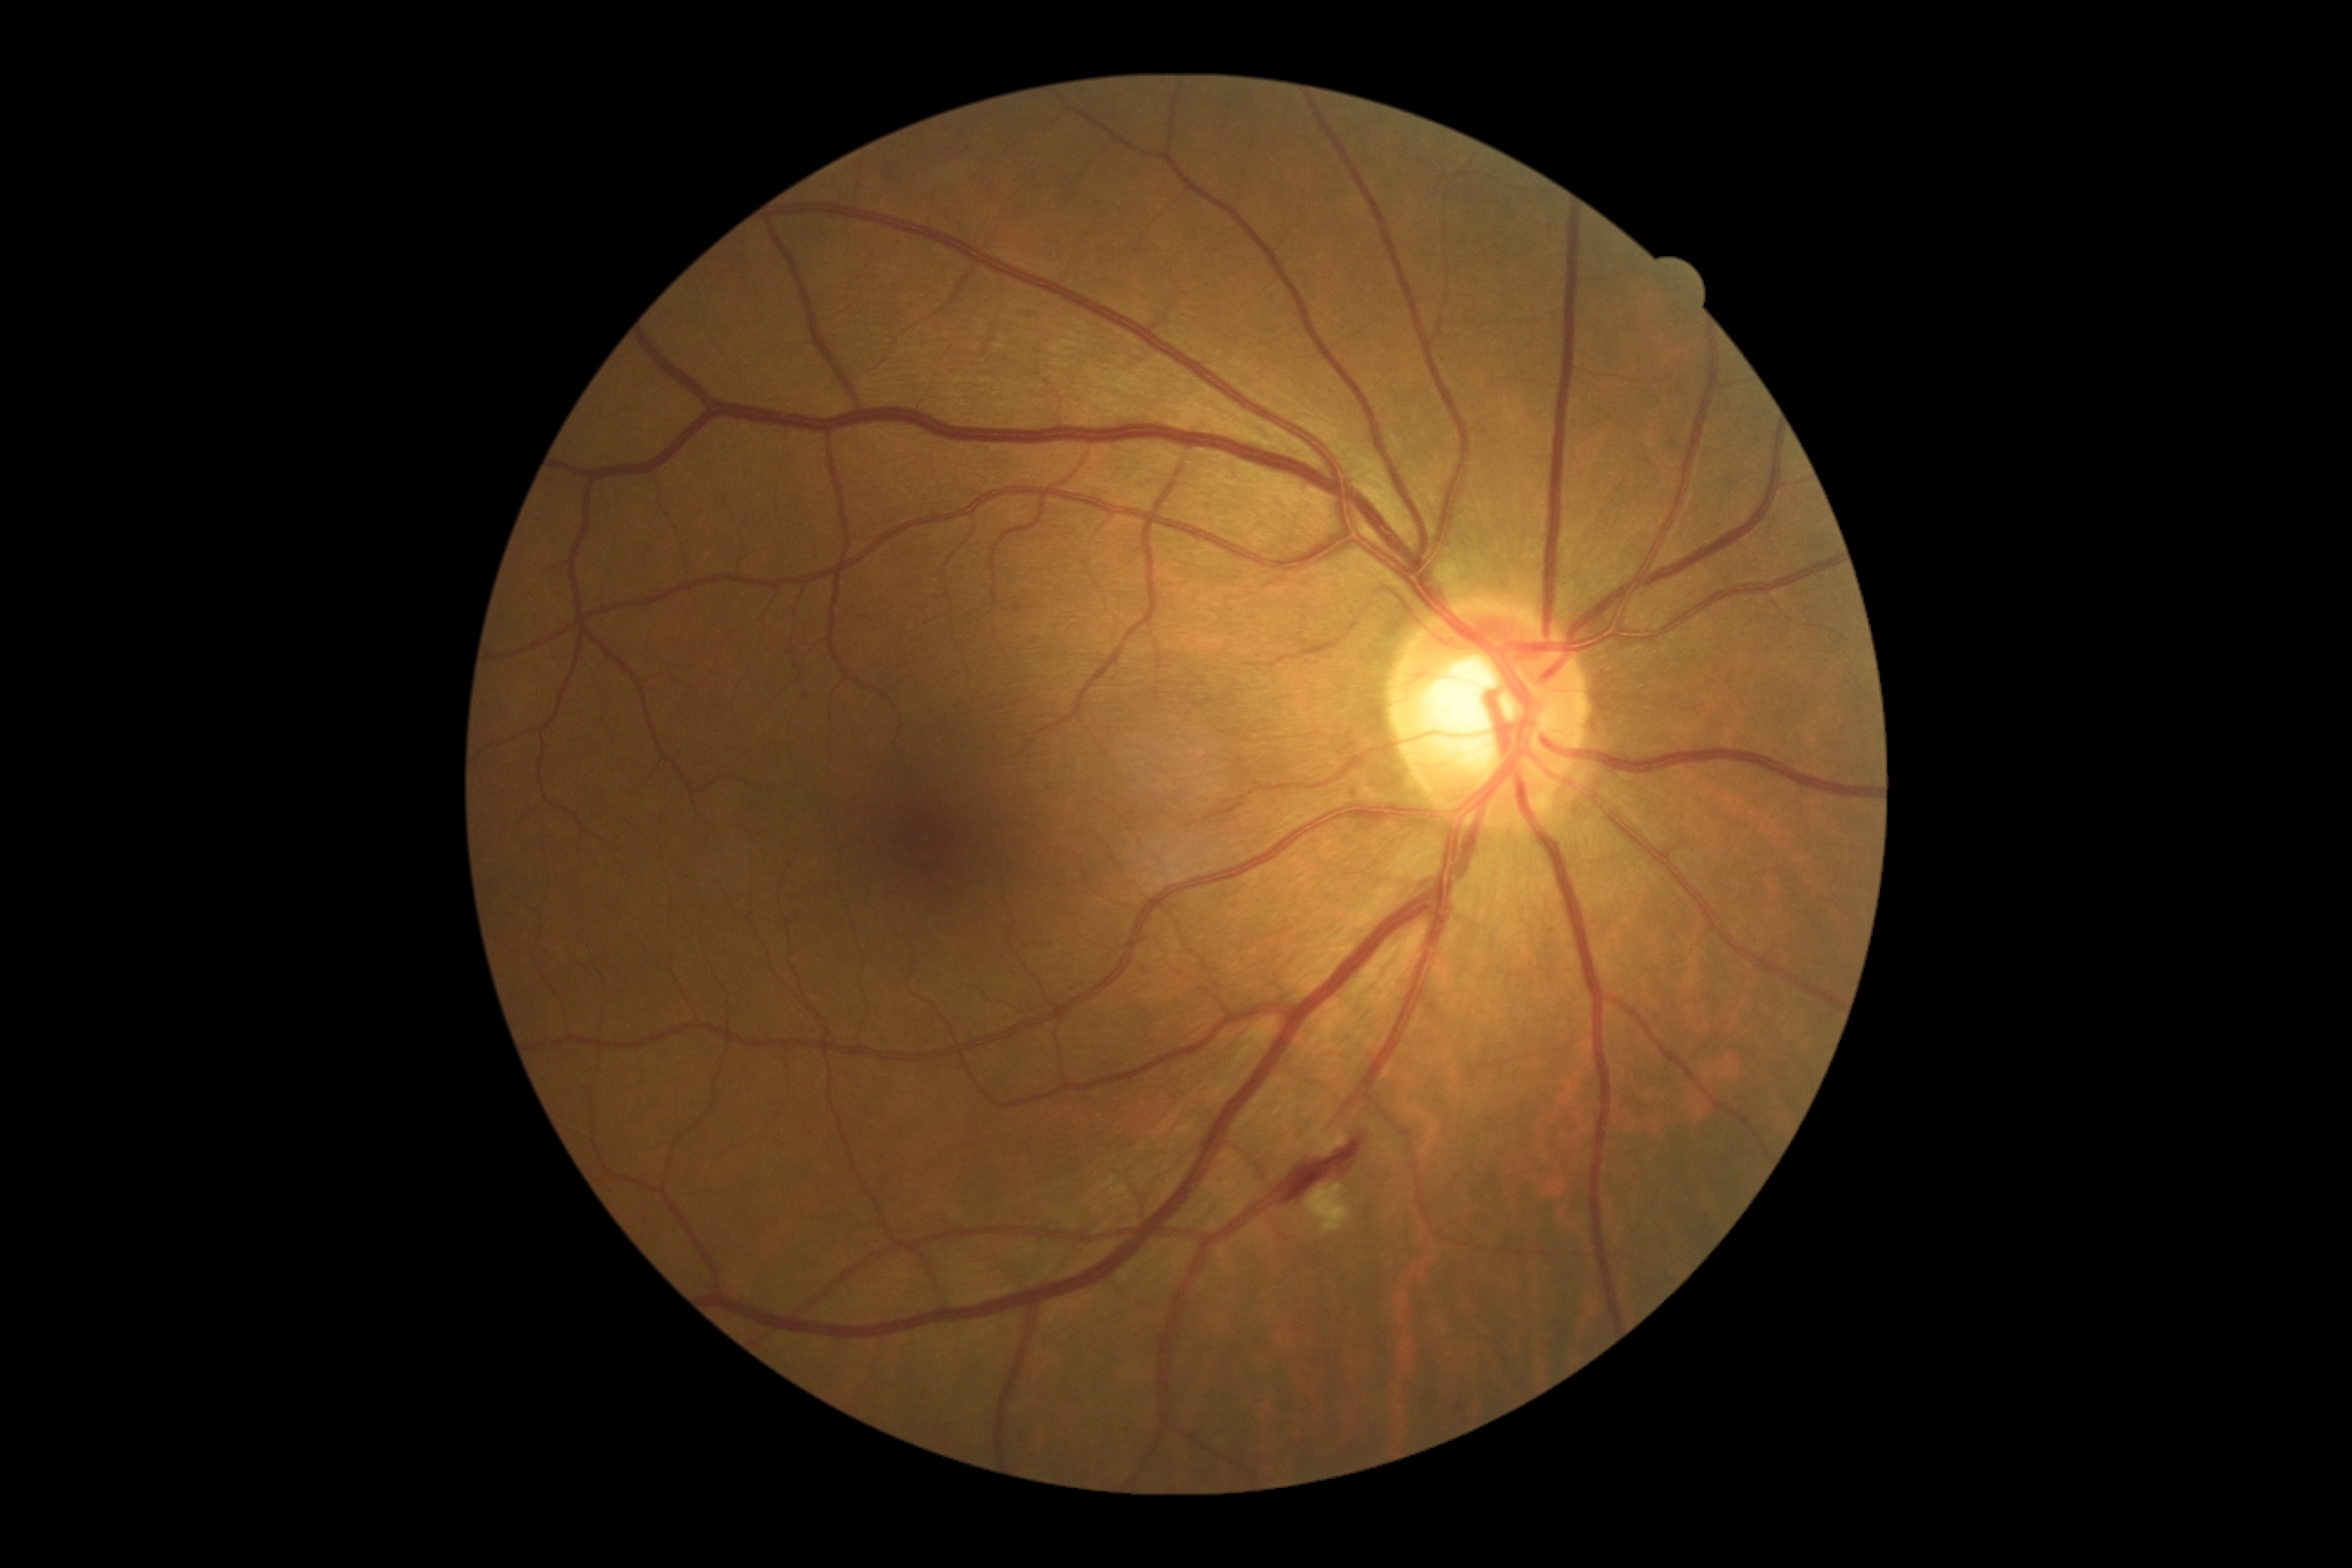 DR: moderate NPDR (grade 2).